Retinal fundus photograph:
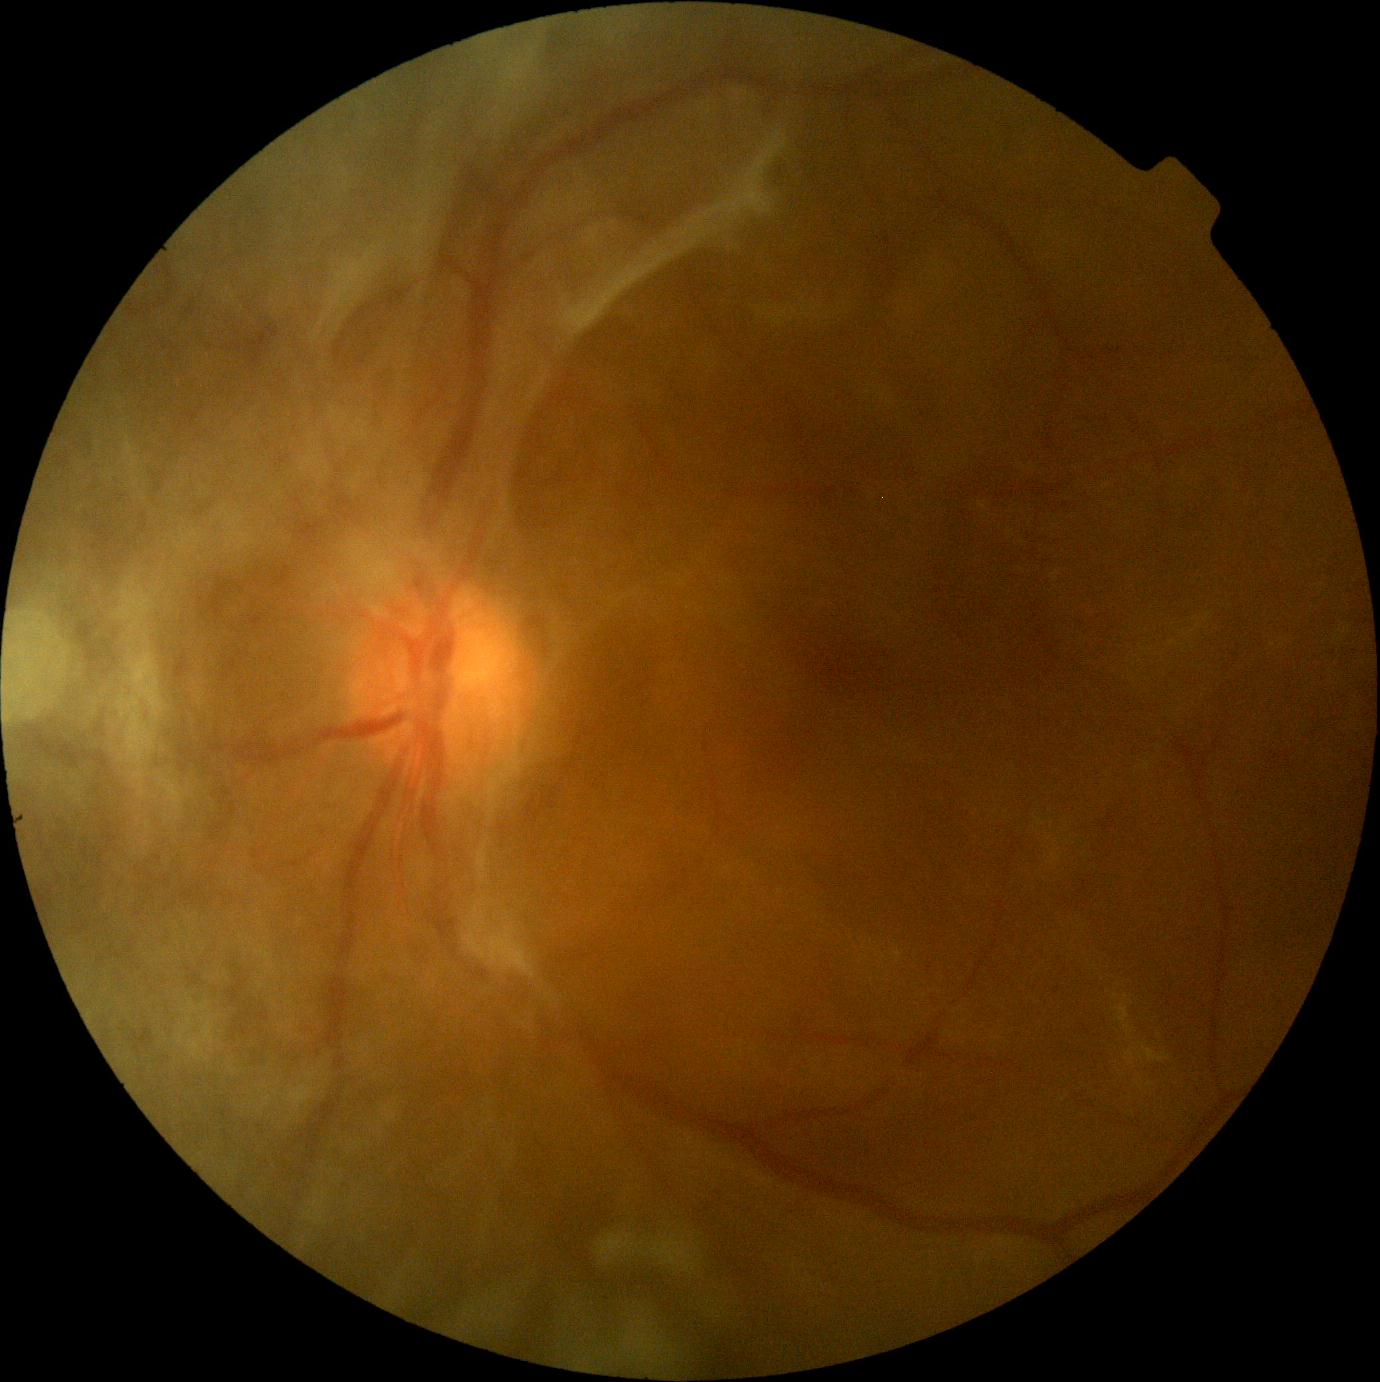 DR grade: 4 (PDR).